Image size 2048x1536 · CFP — 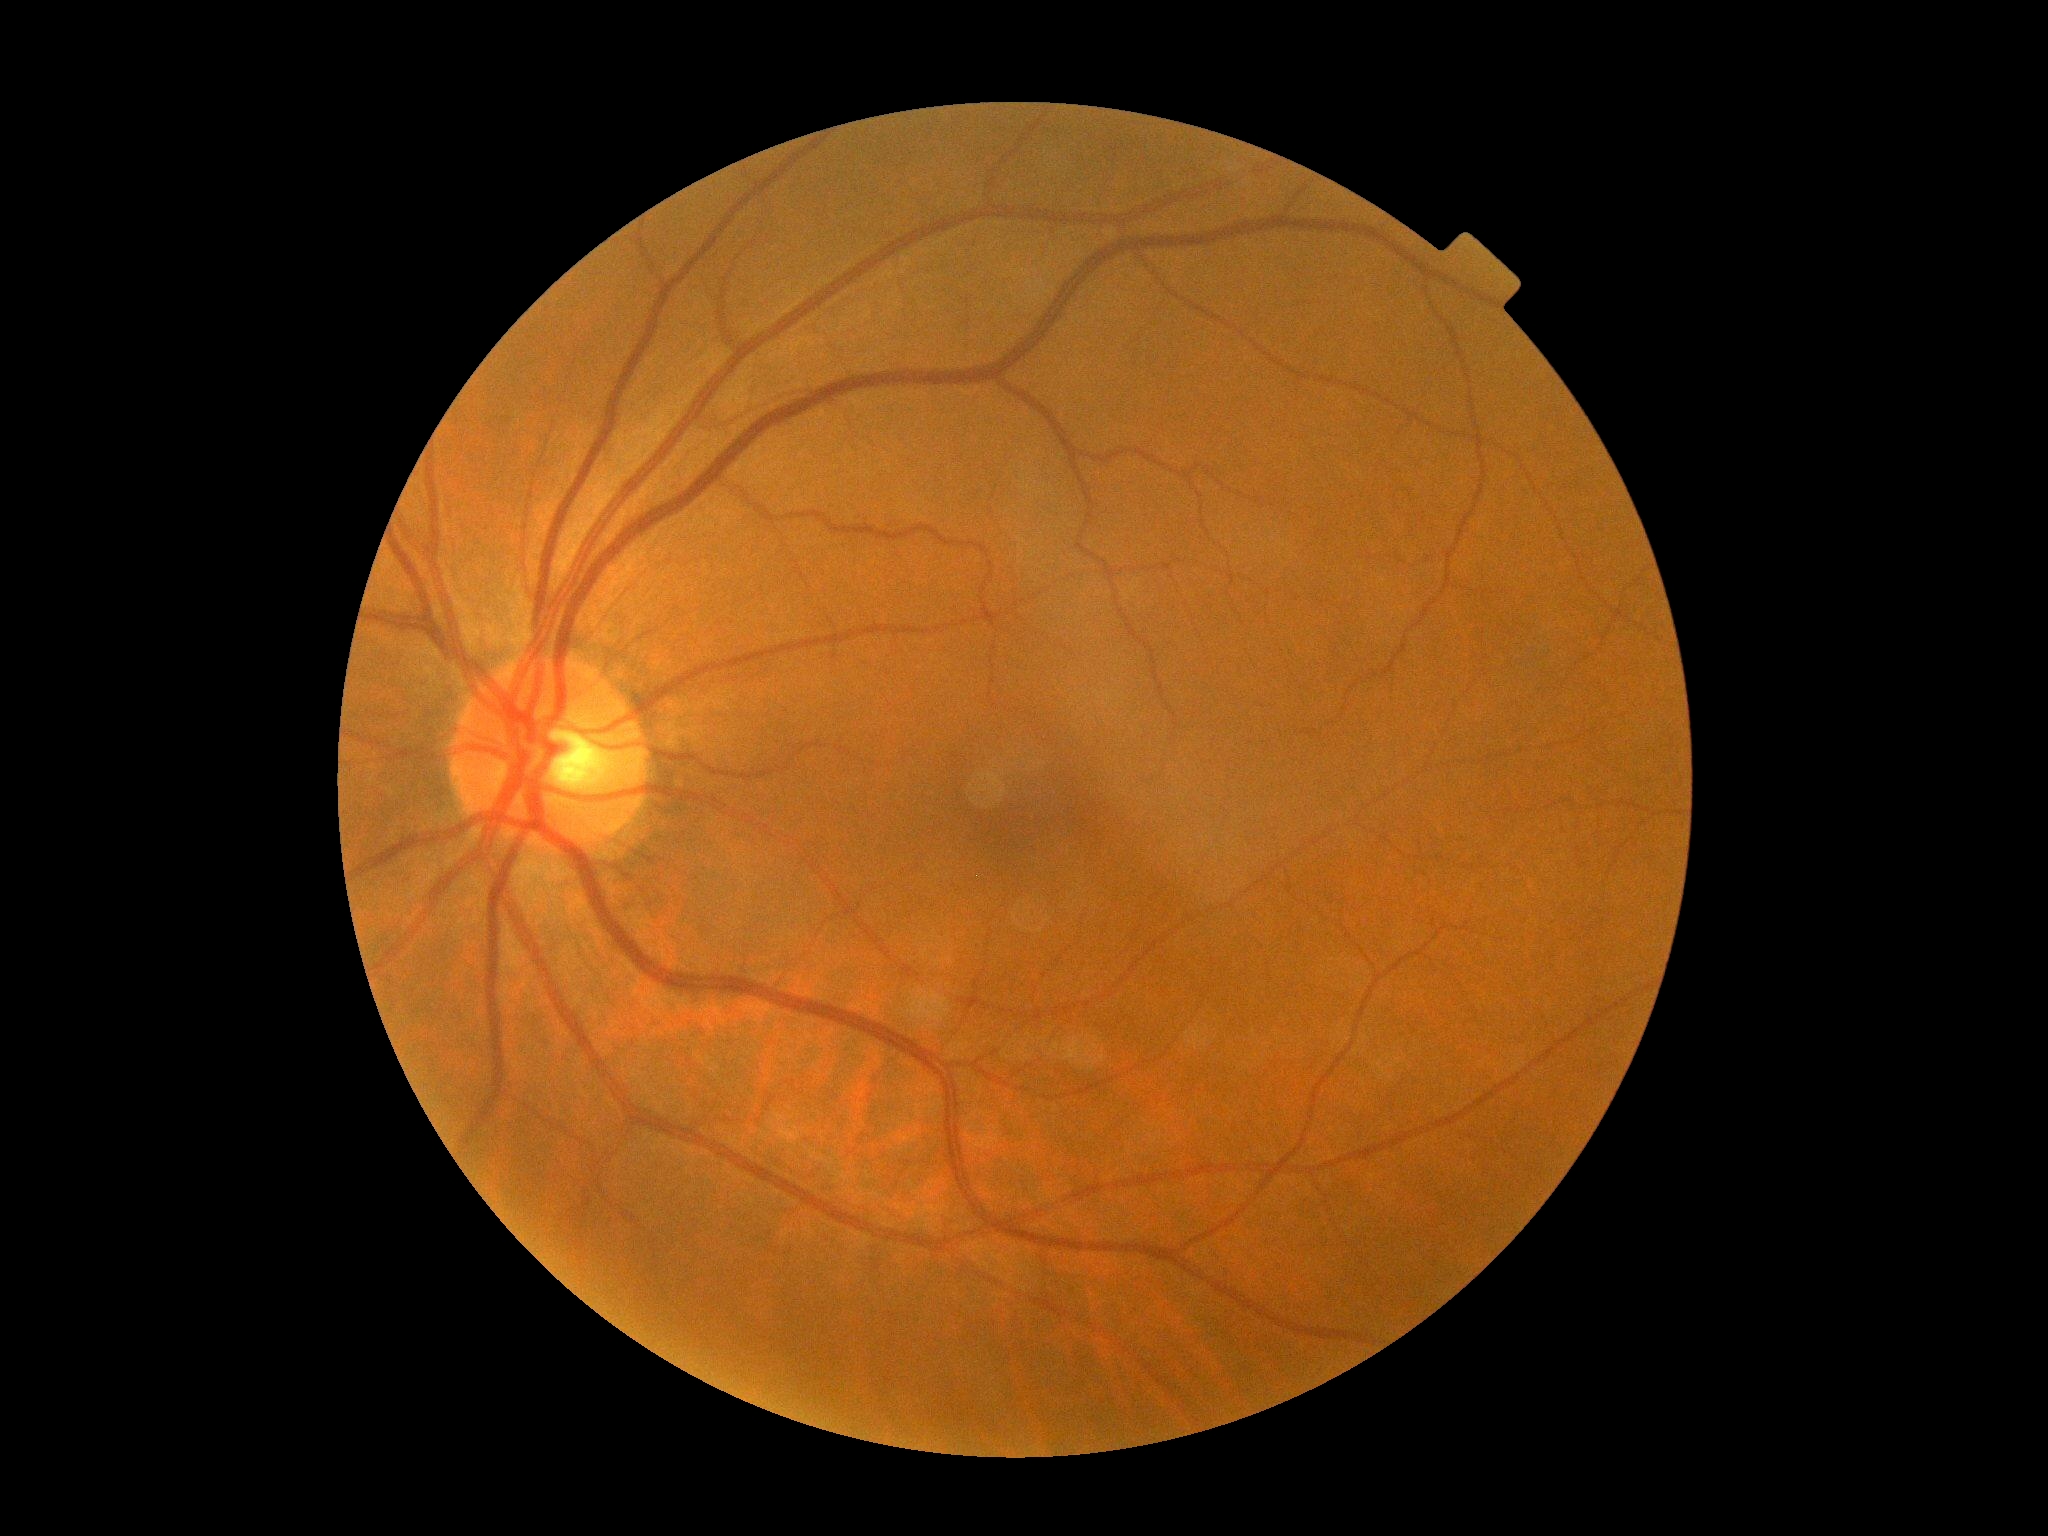

DR impression = no DR findings | diabetic retinopathy (DR) = grade 0.